2352 x 1568 pixels; 45-degree field of view; color fundus image — 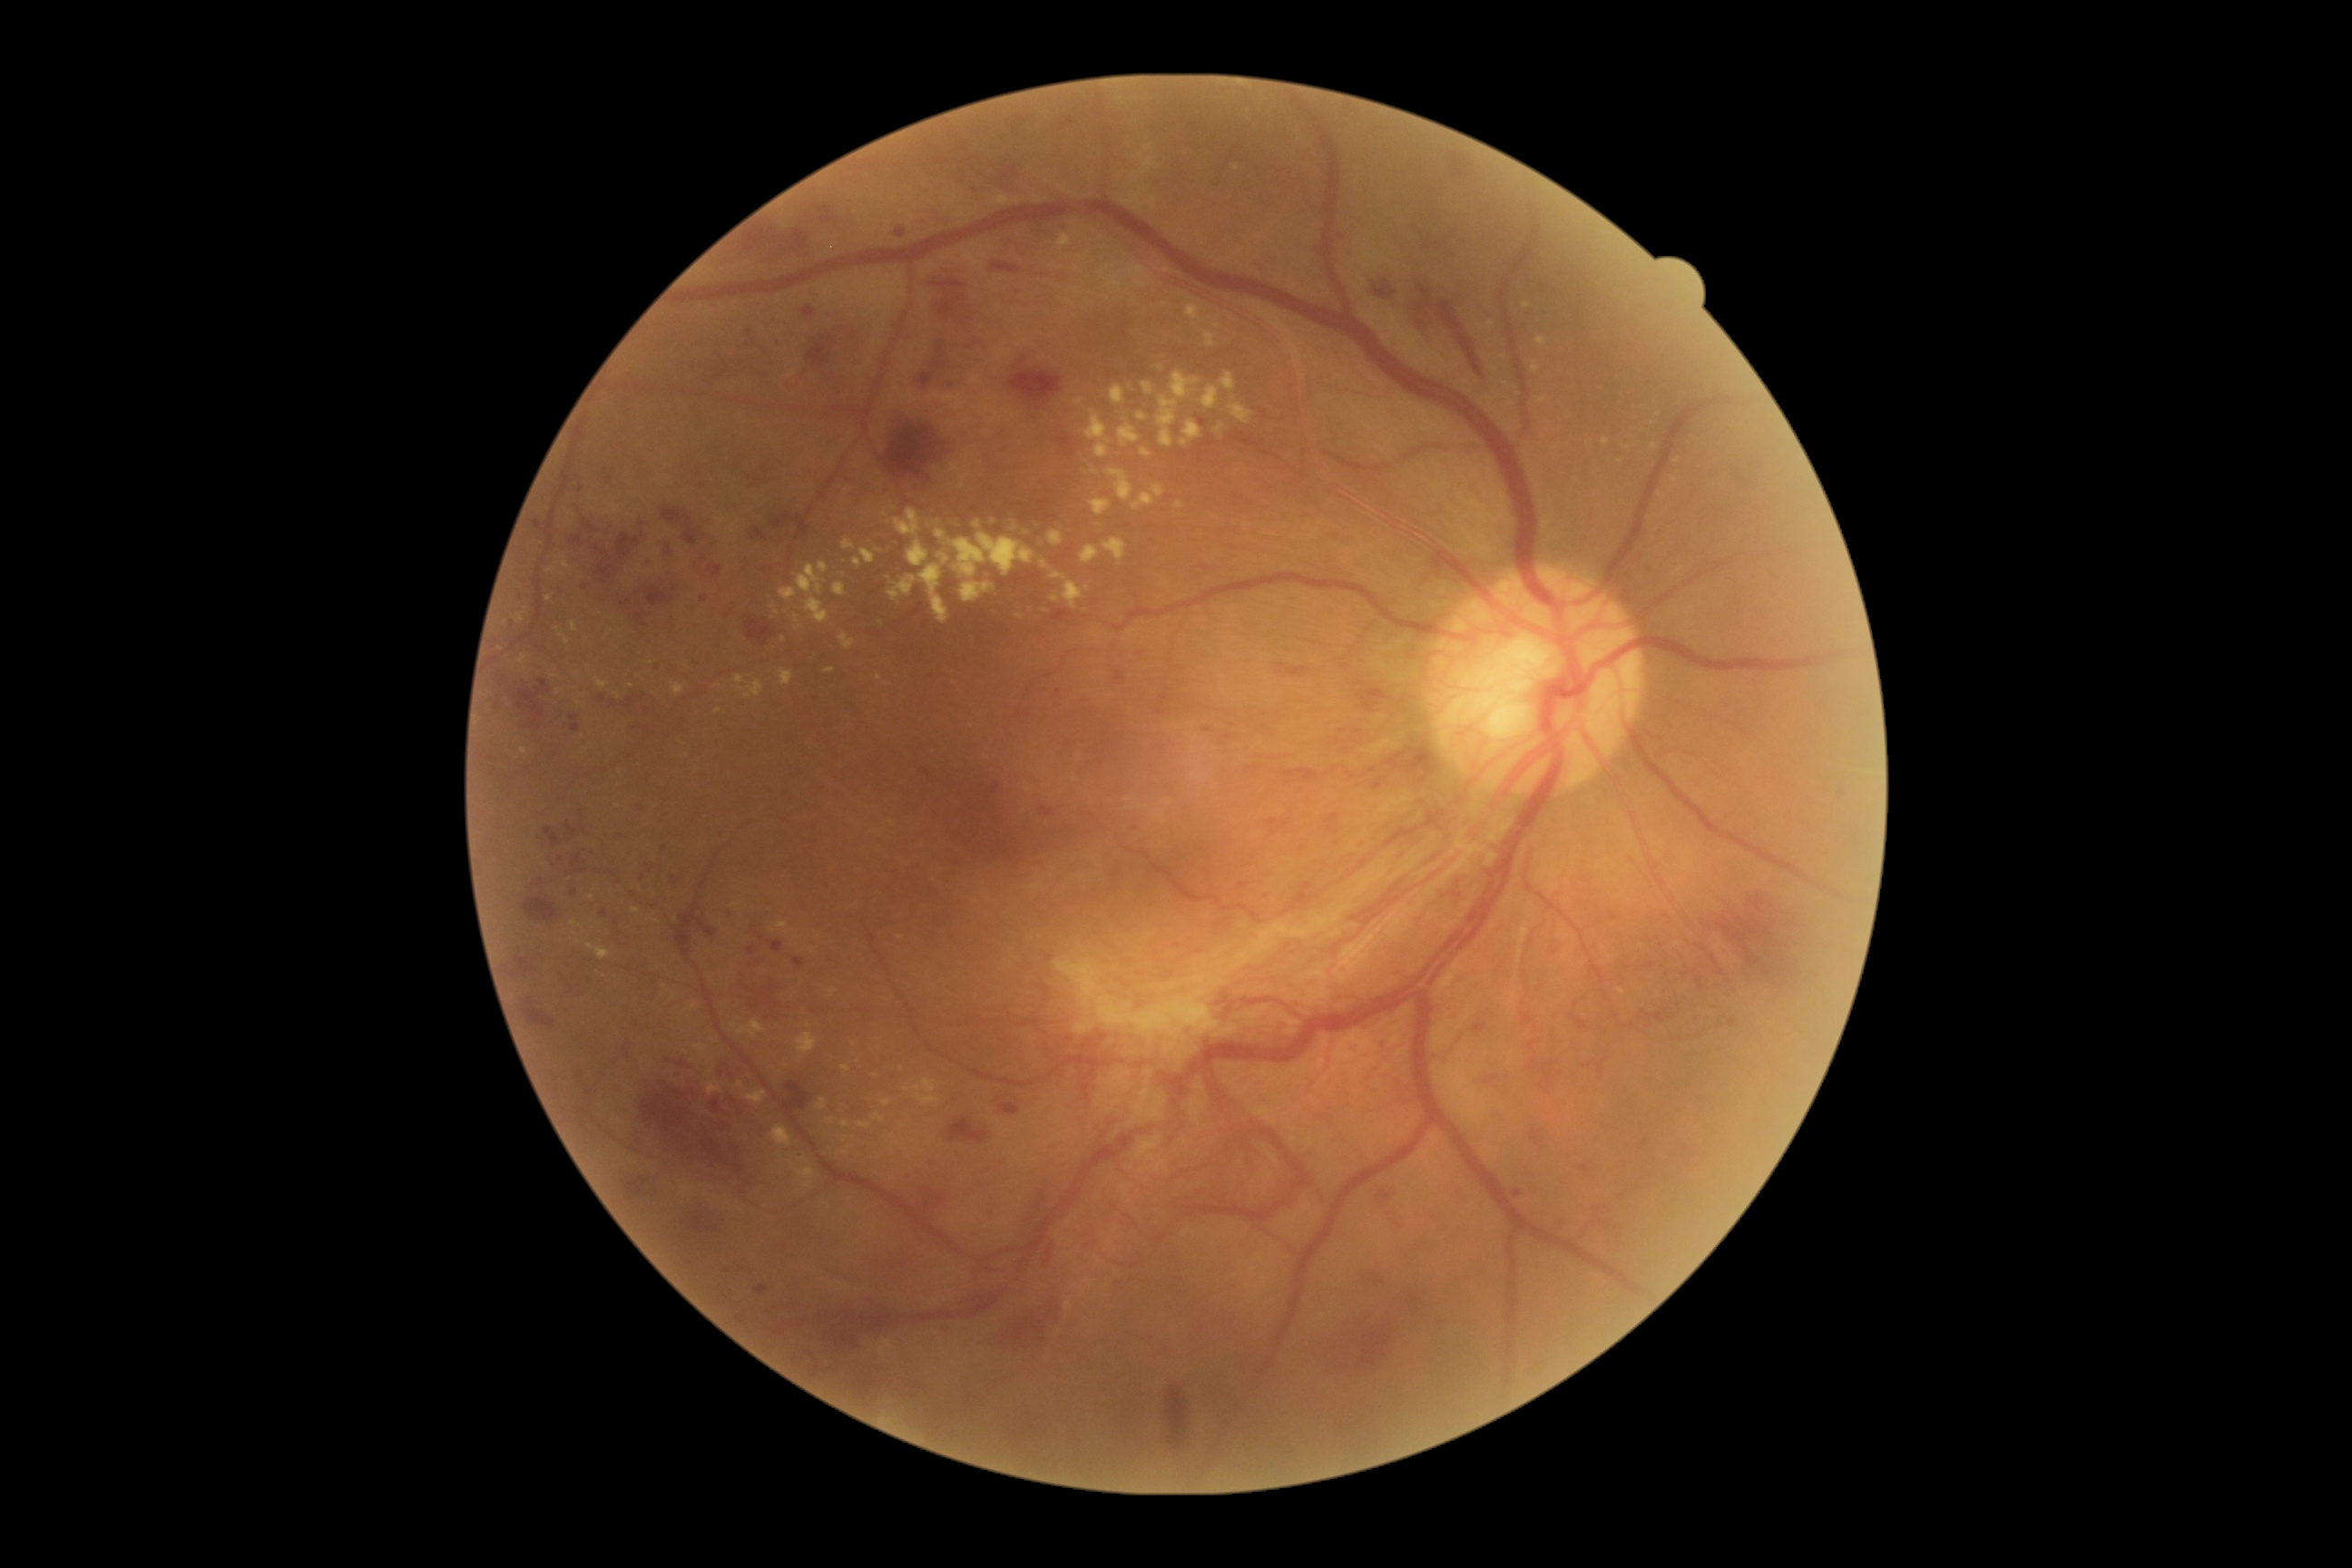 Diabetic retinopathy (DR): 4
Lesions identified (partial list):
hard exudates (EXs) (more not shown): rect(906, 540, 930, 567) | rect(1059, 235, 1072, 248) | rect(1075, 400, 1083, 406) | rect(995, 197, 1006, 208) | rect(914, 1079, 936, 1093) | rect(1164, 801, 1173, 807) | rect(1052, 573, 1083, 609) | rect(841, 1064, 852, 1073) | rect(516, 614, 525, 623) | rect(827, 1117, 836, 1124) | rect(796, 1034, 818, 1054) | rect(881, 1101, 892, 1106) | rect(861, 549, 876, 564)
Small EXs near (631; 686) | (777; 612) | (1677; 461) | (1046; 611) | (1160; 369)
hemorrhages (HEs) (more not shown): rect(992, 785, 1001, 796) | rect(1596, 1224, 1625, 1231) | rect(970, 1266, 1001, 1275) | rect(1041, 807, 1055, 818) | rect(1059, 220, 1066, 231) | rect(783, 516, 789, 524) | rect(616, 692, 638, 710) | rect(632, 611, 645, 631) | rect(516, 680, 551, 727) | rect(727, 226, 808, 259) | rect(1366, 691, 1386, 700) | rect(544, 828, 560, 848) | rect(527, 1008, 556, 1030) | rect(709, 567, 721, 576) | rect(524, 897, 558, 923) | rect(950, 1119, 990, 1144) | rect(879, 411, 954, 485) | rect(1373, 783, 1382, 790)
Small HEs near (1340; 730)